No pharmacologic dilation — 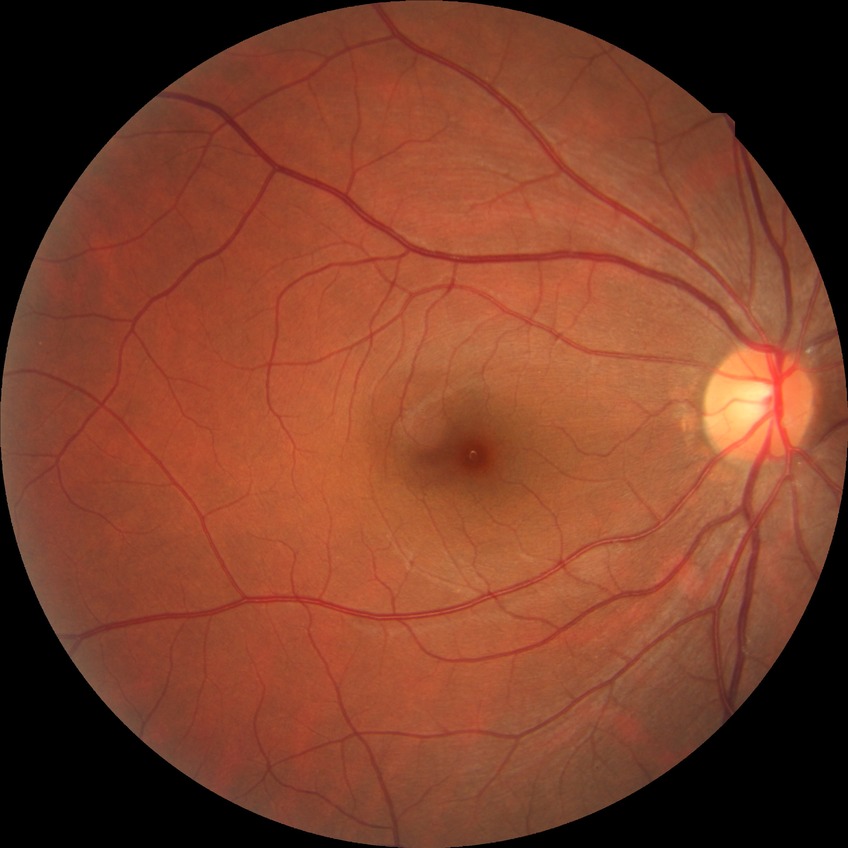 retinopathy stage: no diabetic retinopathy.